73-year-old patient. Woman. 30-degree field of view. Intraocular pressure: 19 mmHg. Fundus photo — 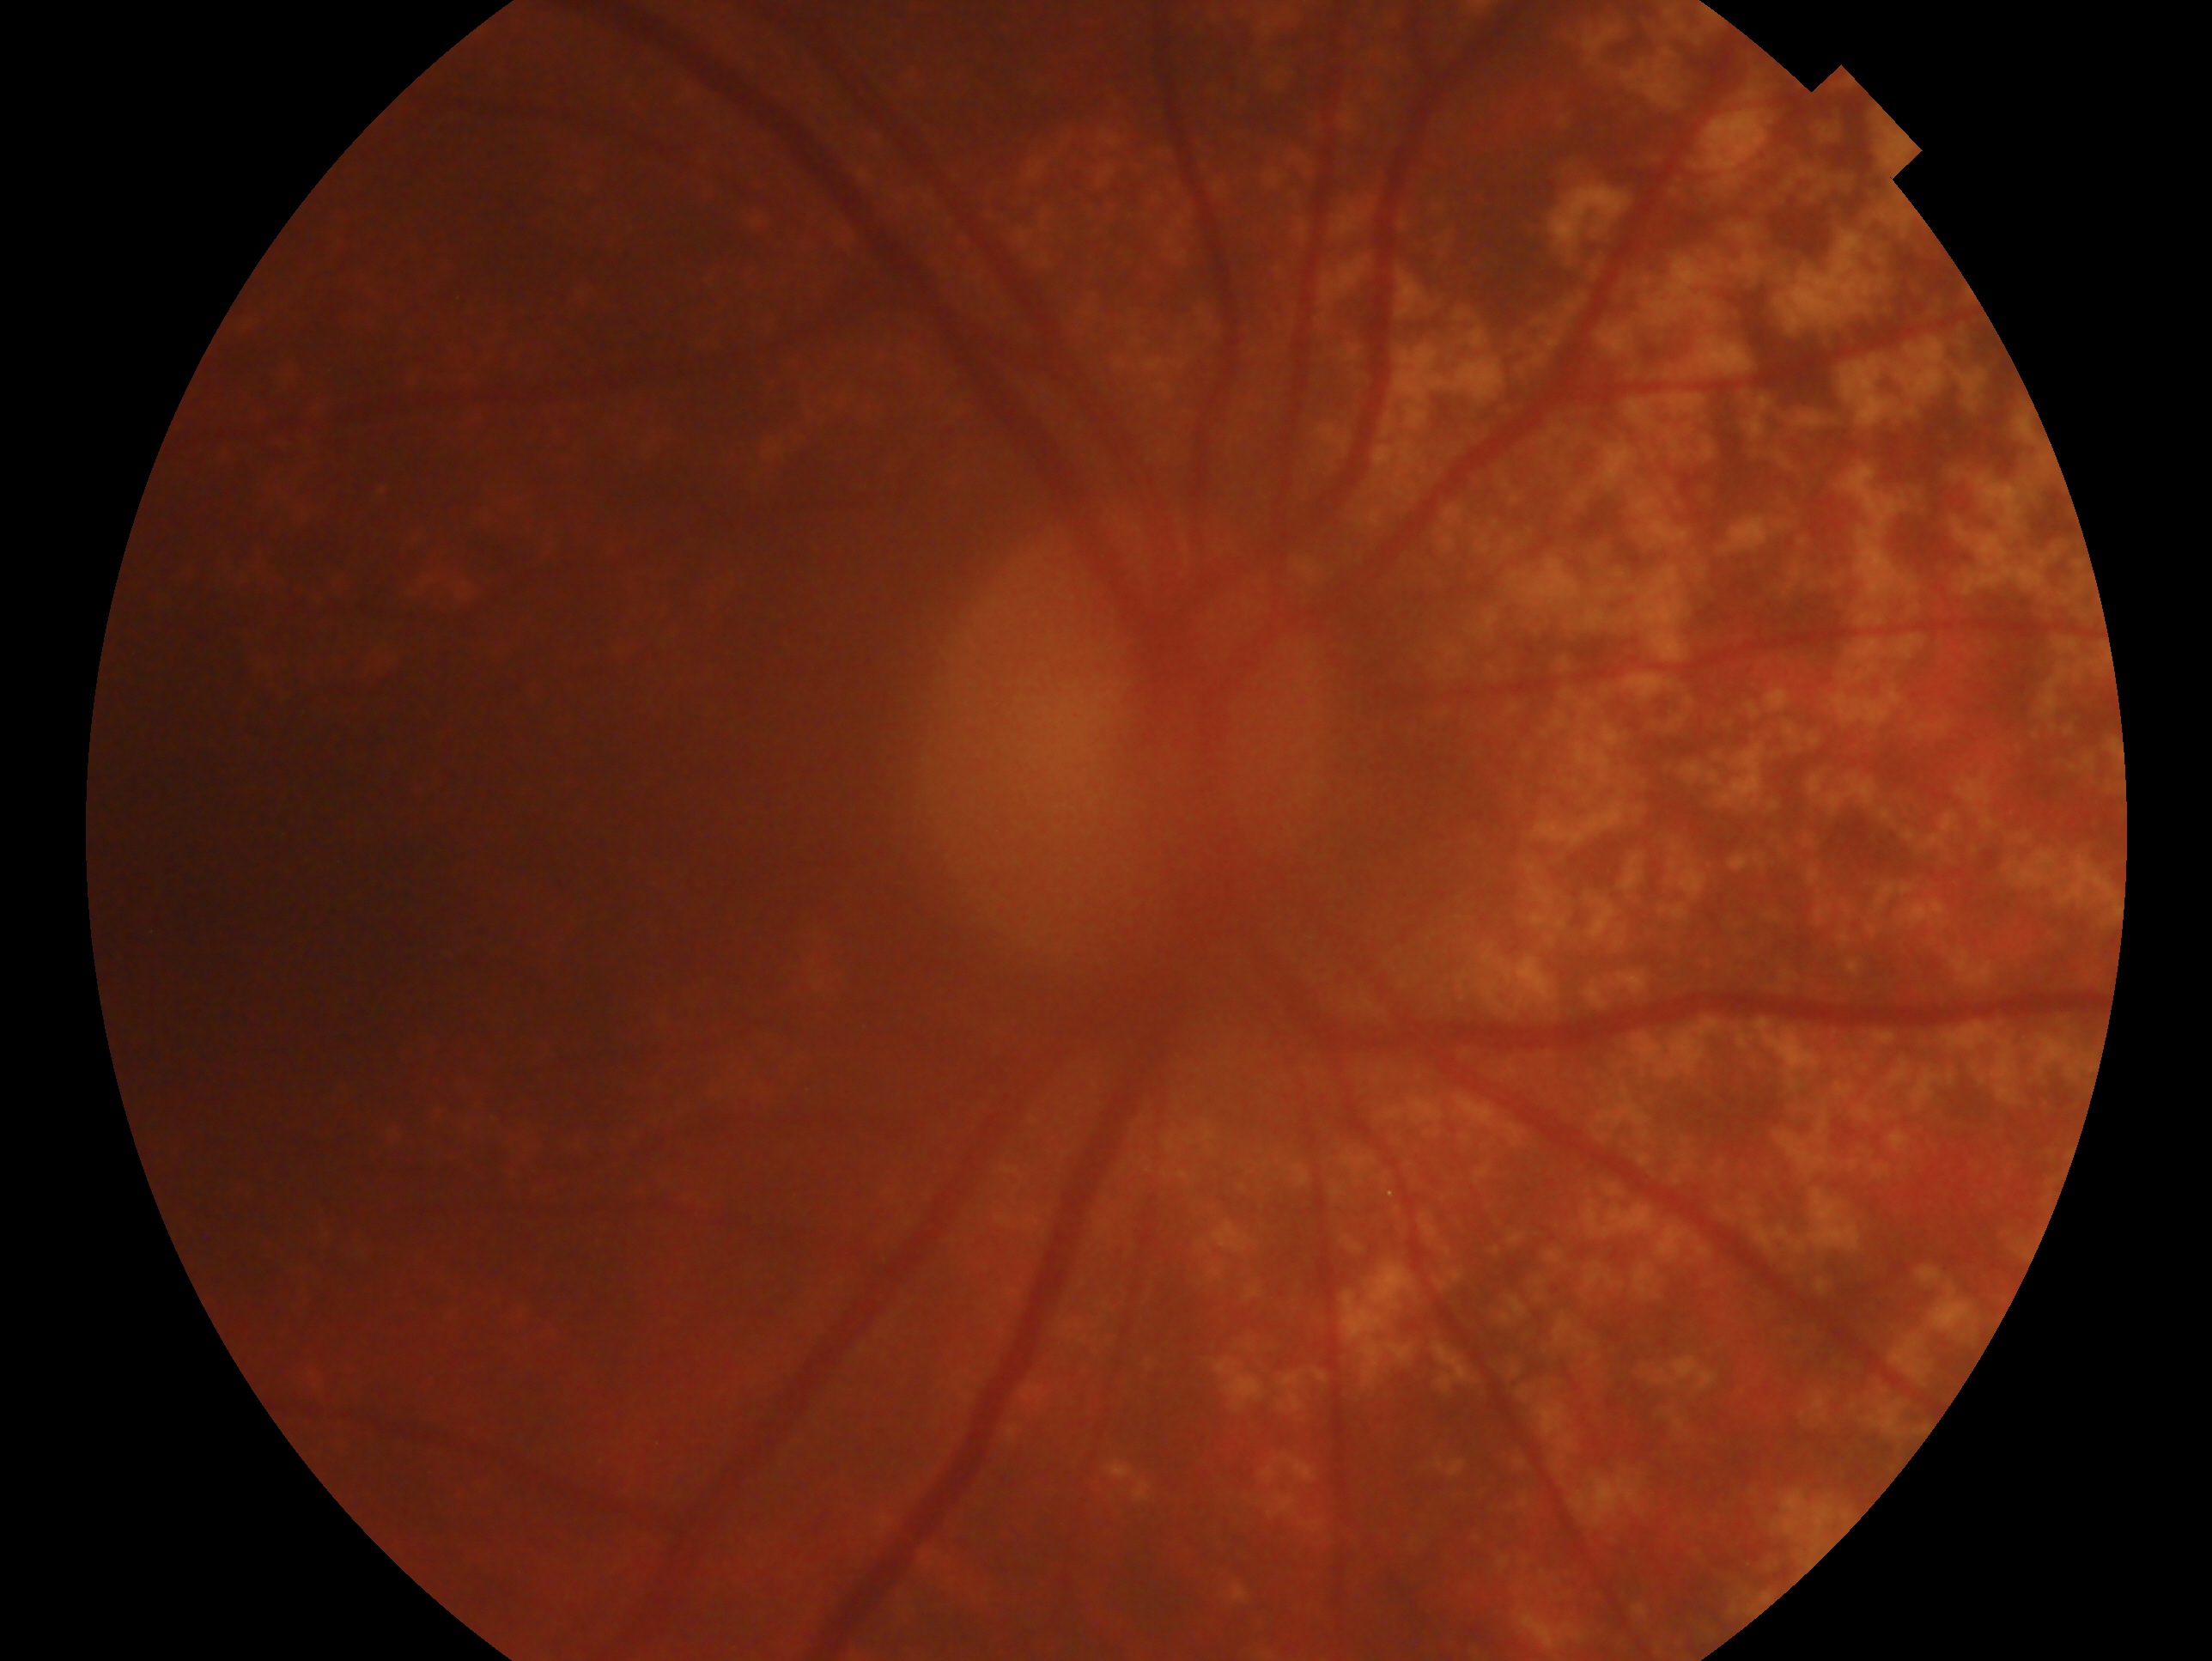 Glaucoma diagnosis — no evidence of glaucoma. Eye: right eye.